Graded on the modified Davis scale · posterior pole photograph: 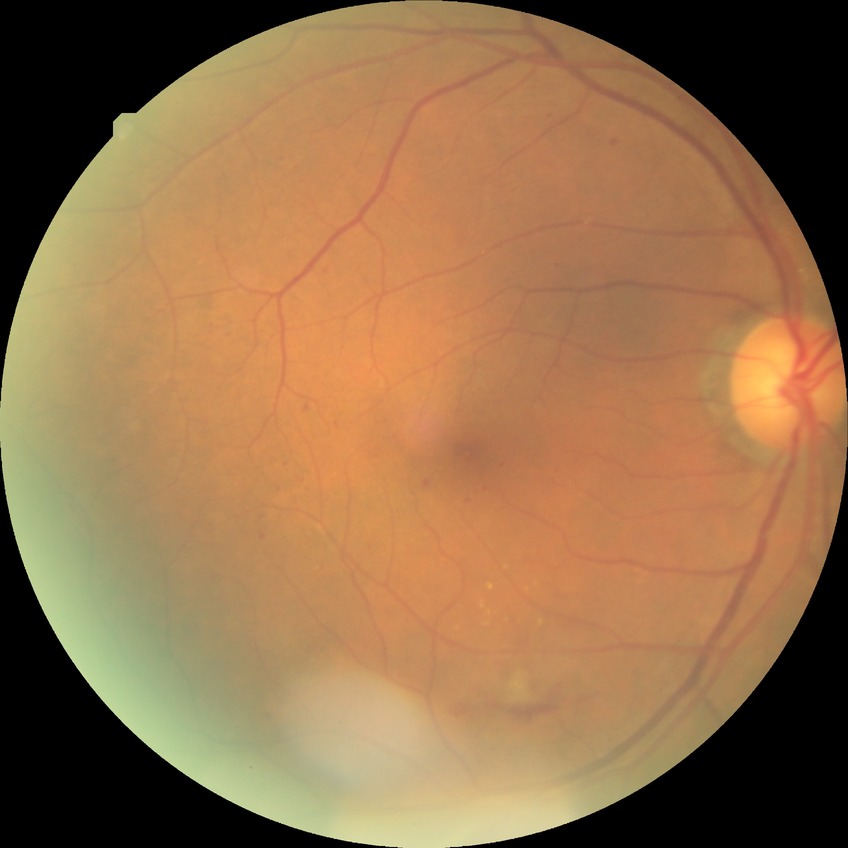

Davis stage = PPDR